848 by 848 pixels; 45° FOV; NIDEK AFC-230 fundus camera; fundus photo; without pupil dilation — 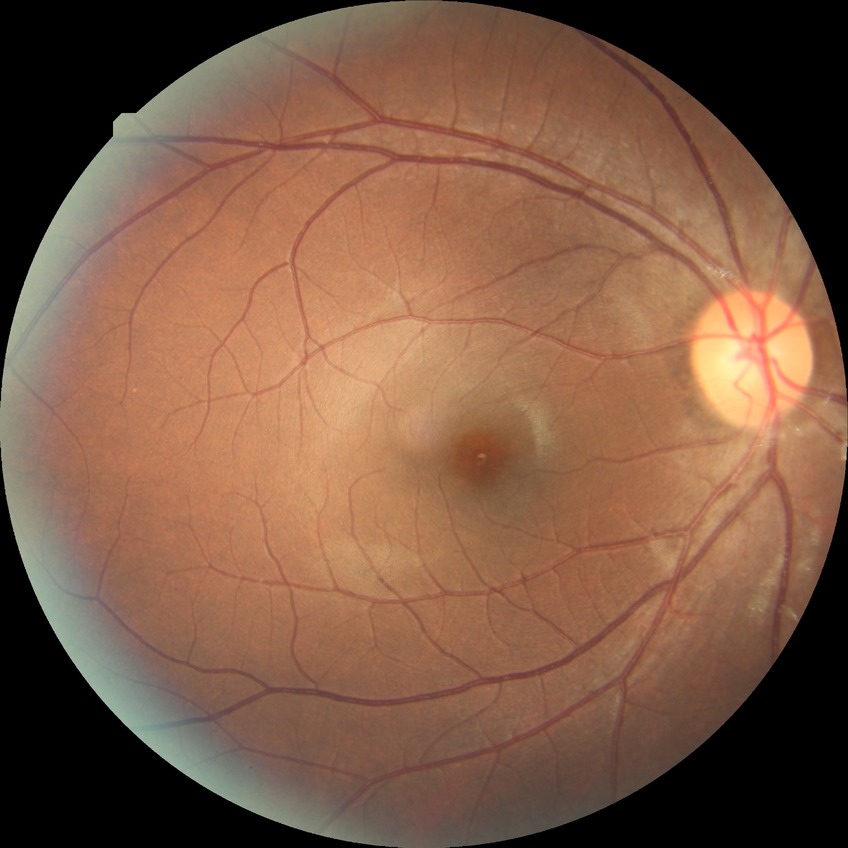

diabetic retinopathy (DR): NDR (no diabetic retinopathy).